Color fundus photograph — 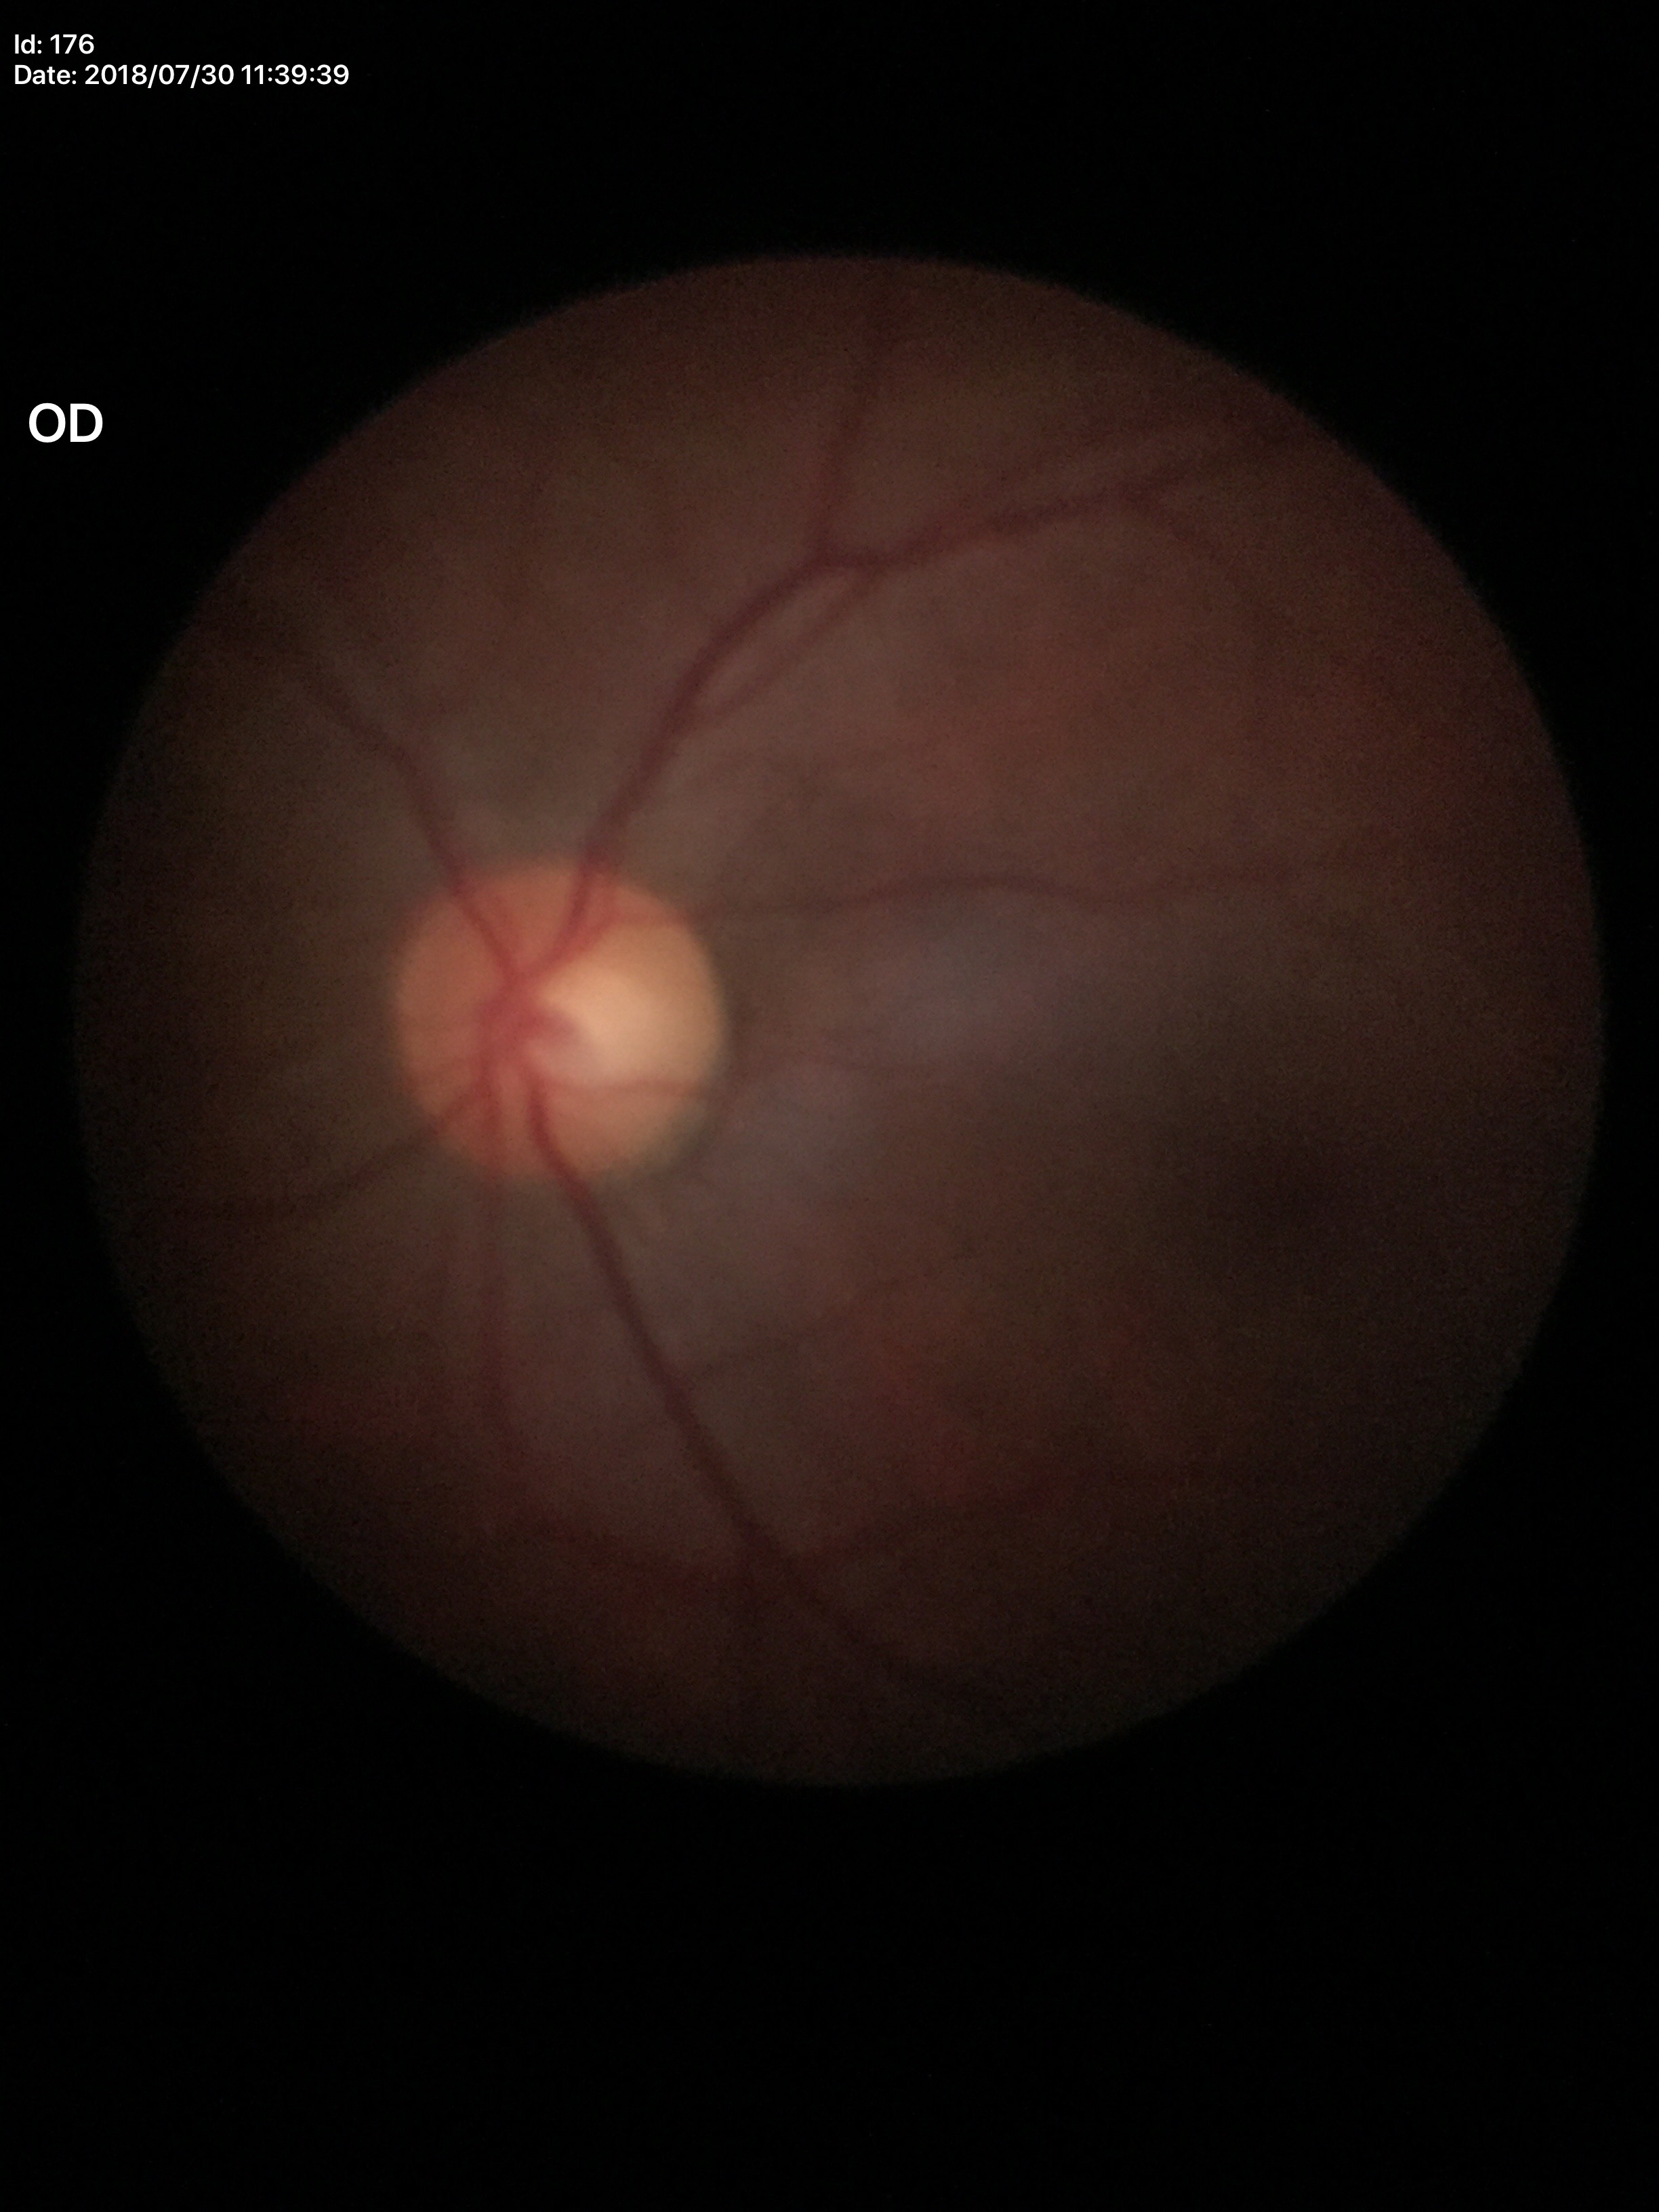 Glaucoma assessment=not suspect | vertical cup-disc ratio=0.47